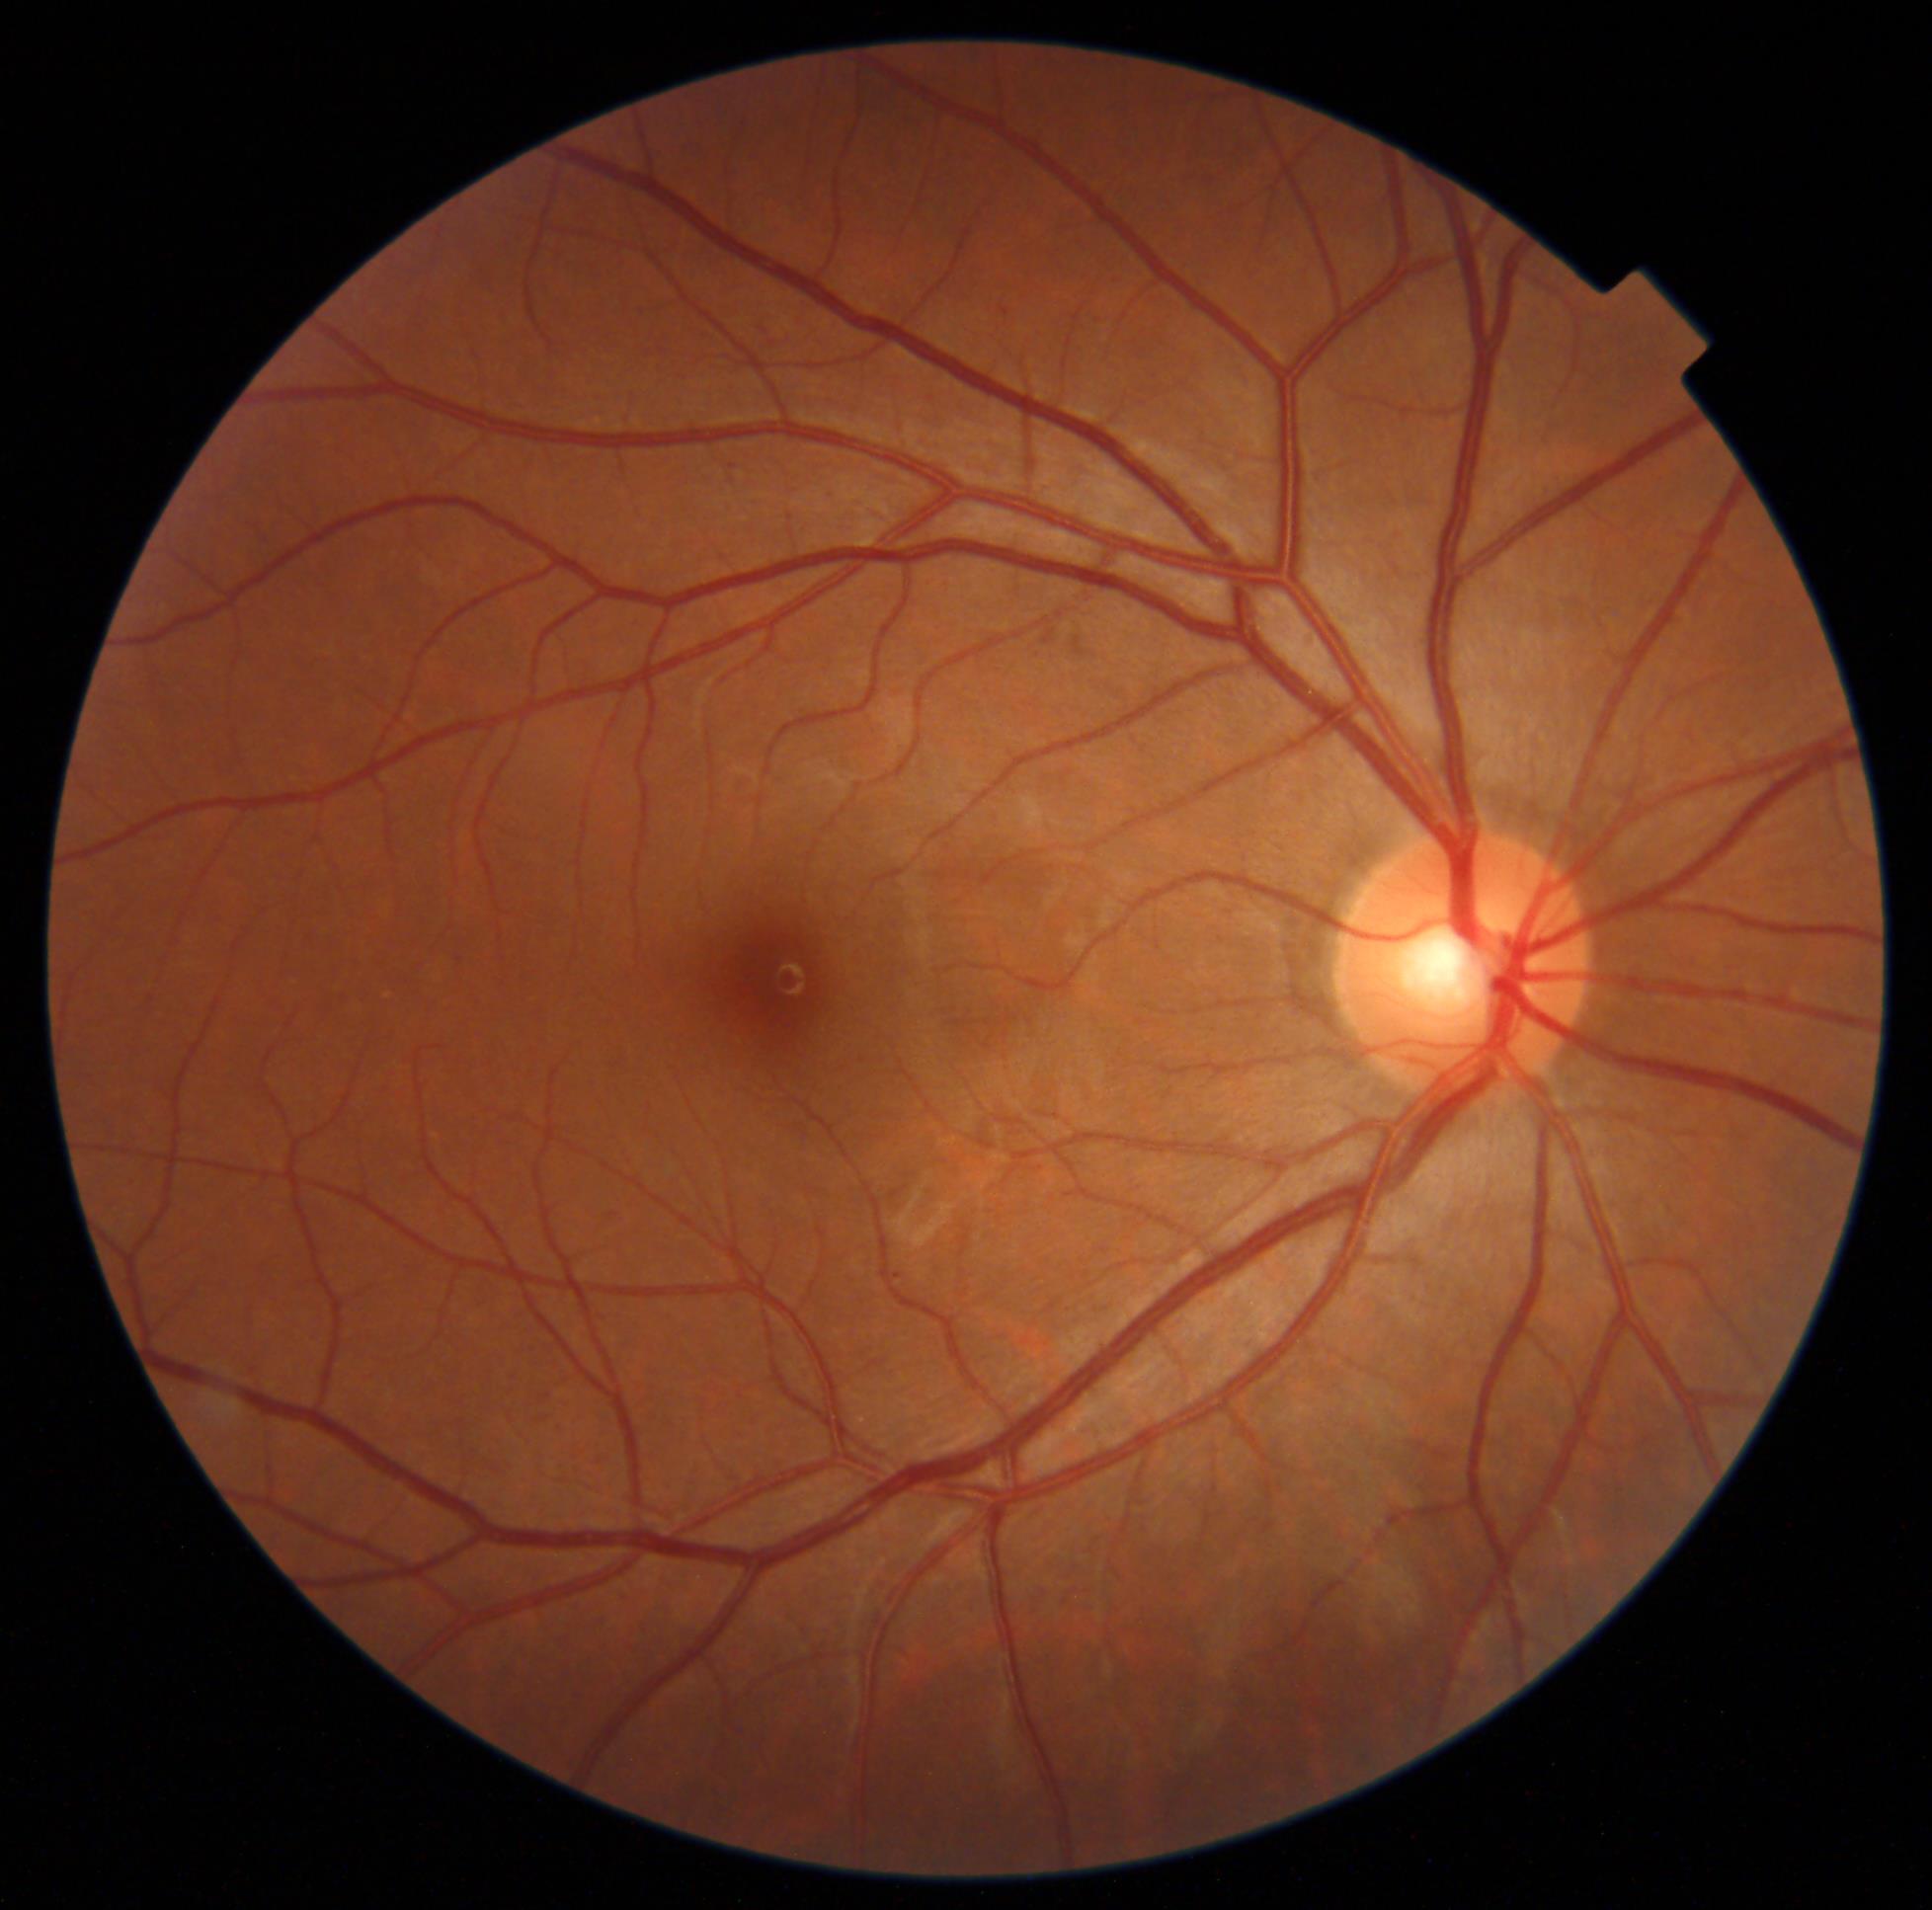 Diabetic retinopathy (DR): grade 1 (mild NPDR).